No pharmacologic dilation · NIDEK AFC-230 — 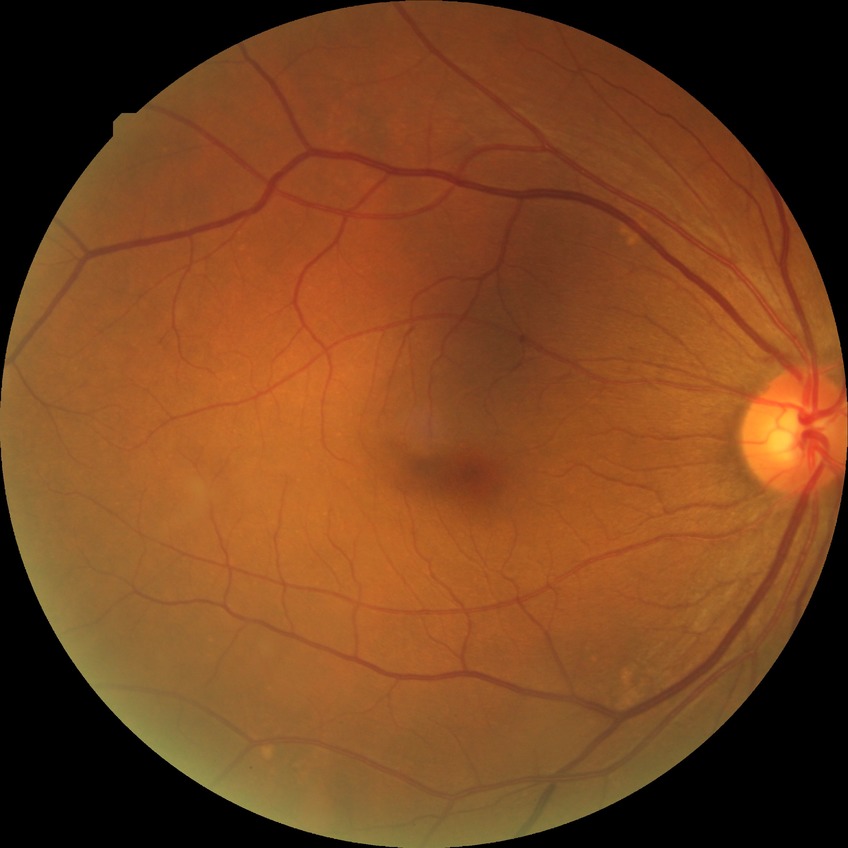
Diabetic retinopathy severity: simple diabetic retinopathy.